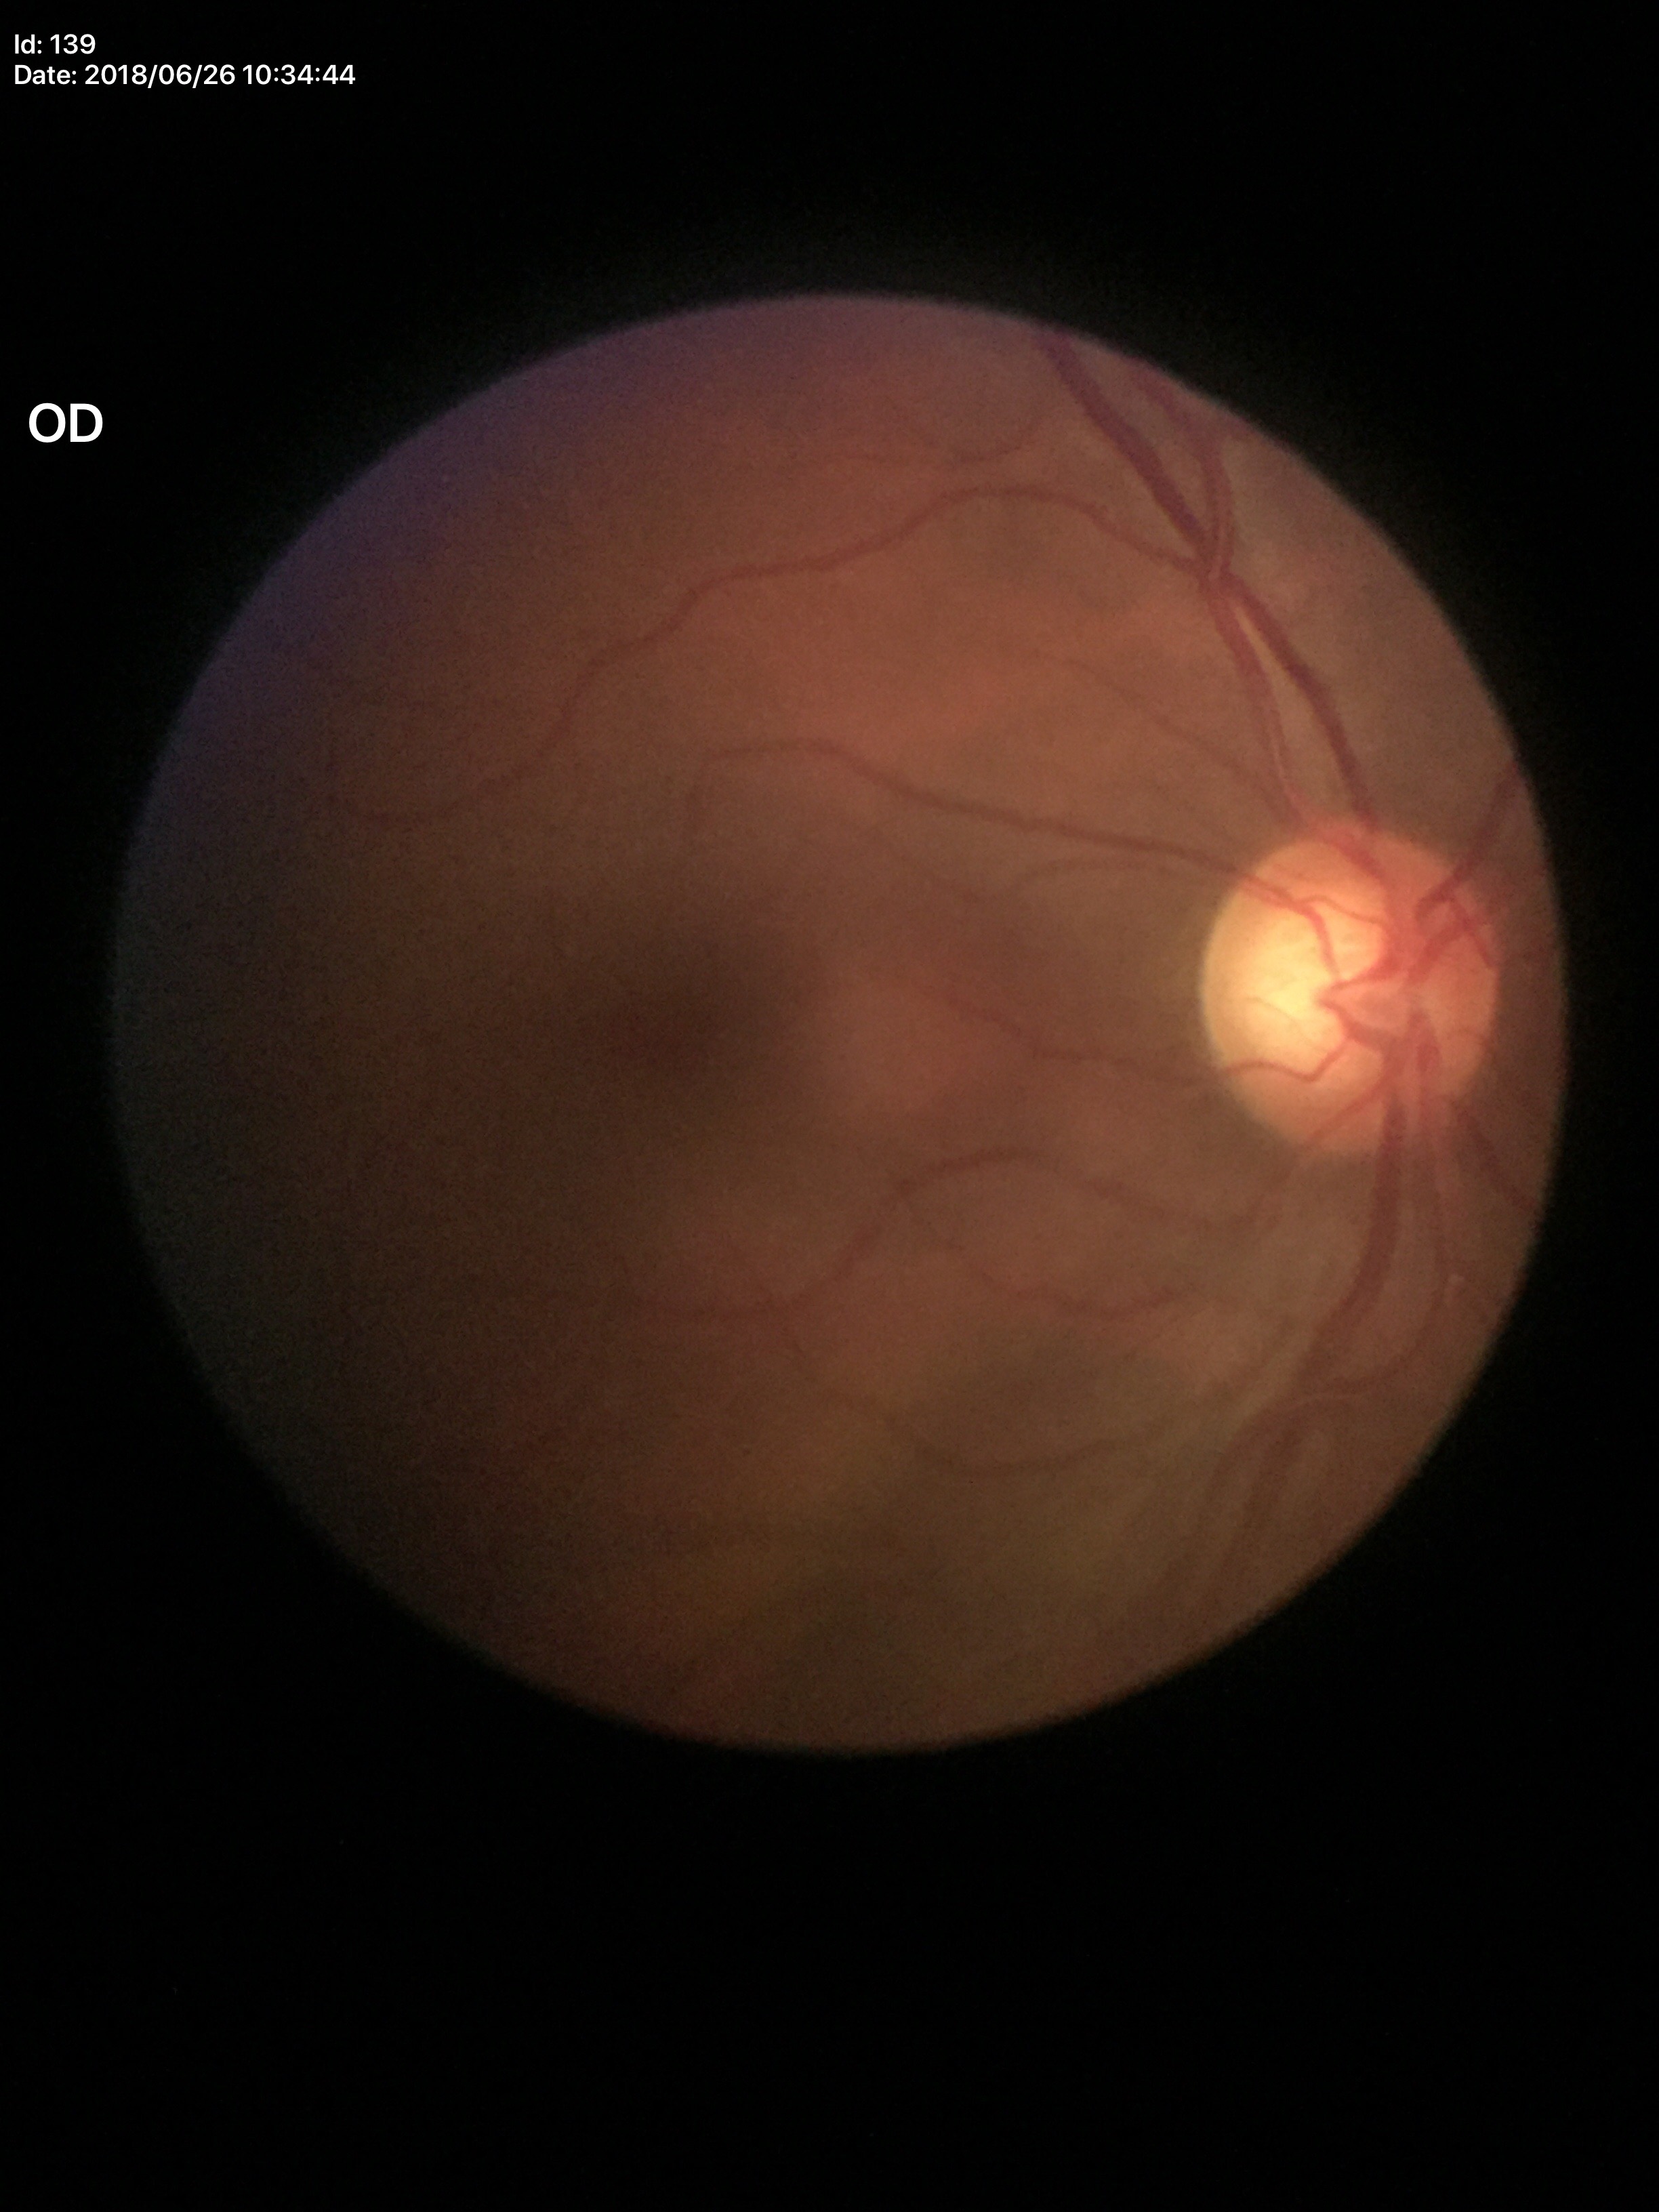

Glaucoma evaluation: suspect (all 5 graders flagged glaucoma suspect); VCDR: 0.66.